1960 x 1897 pixels, FOV: 45 degrees.
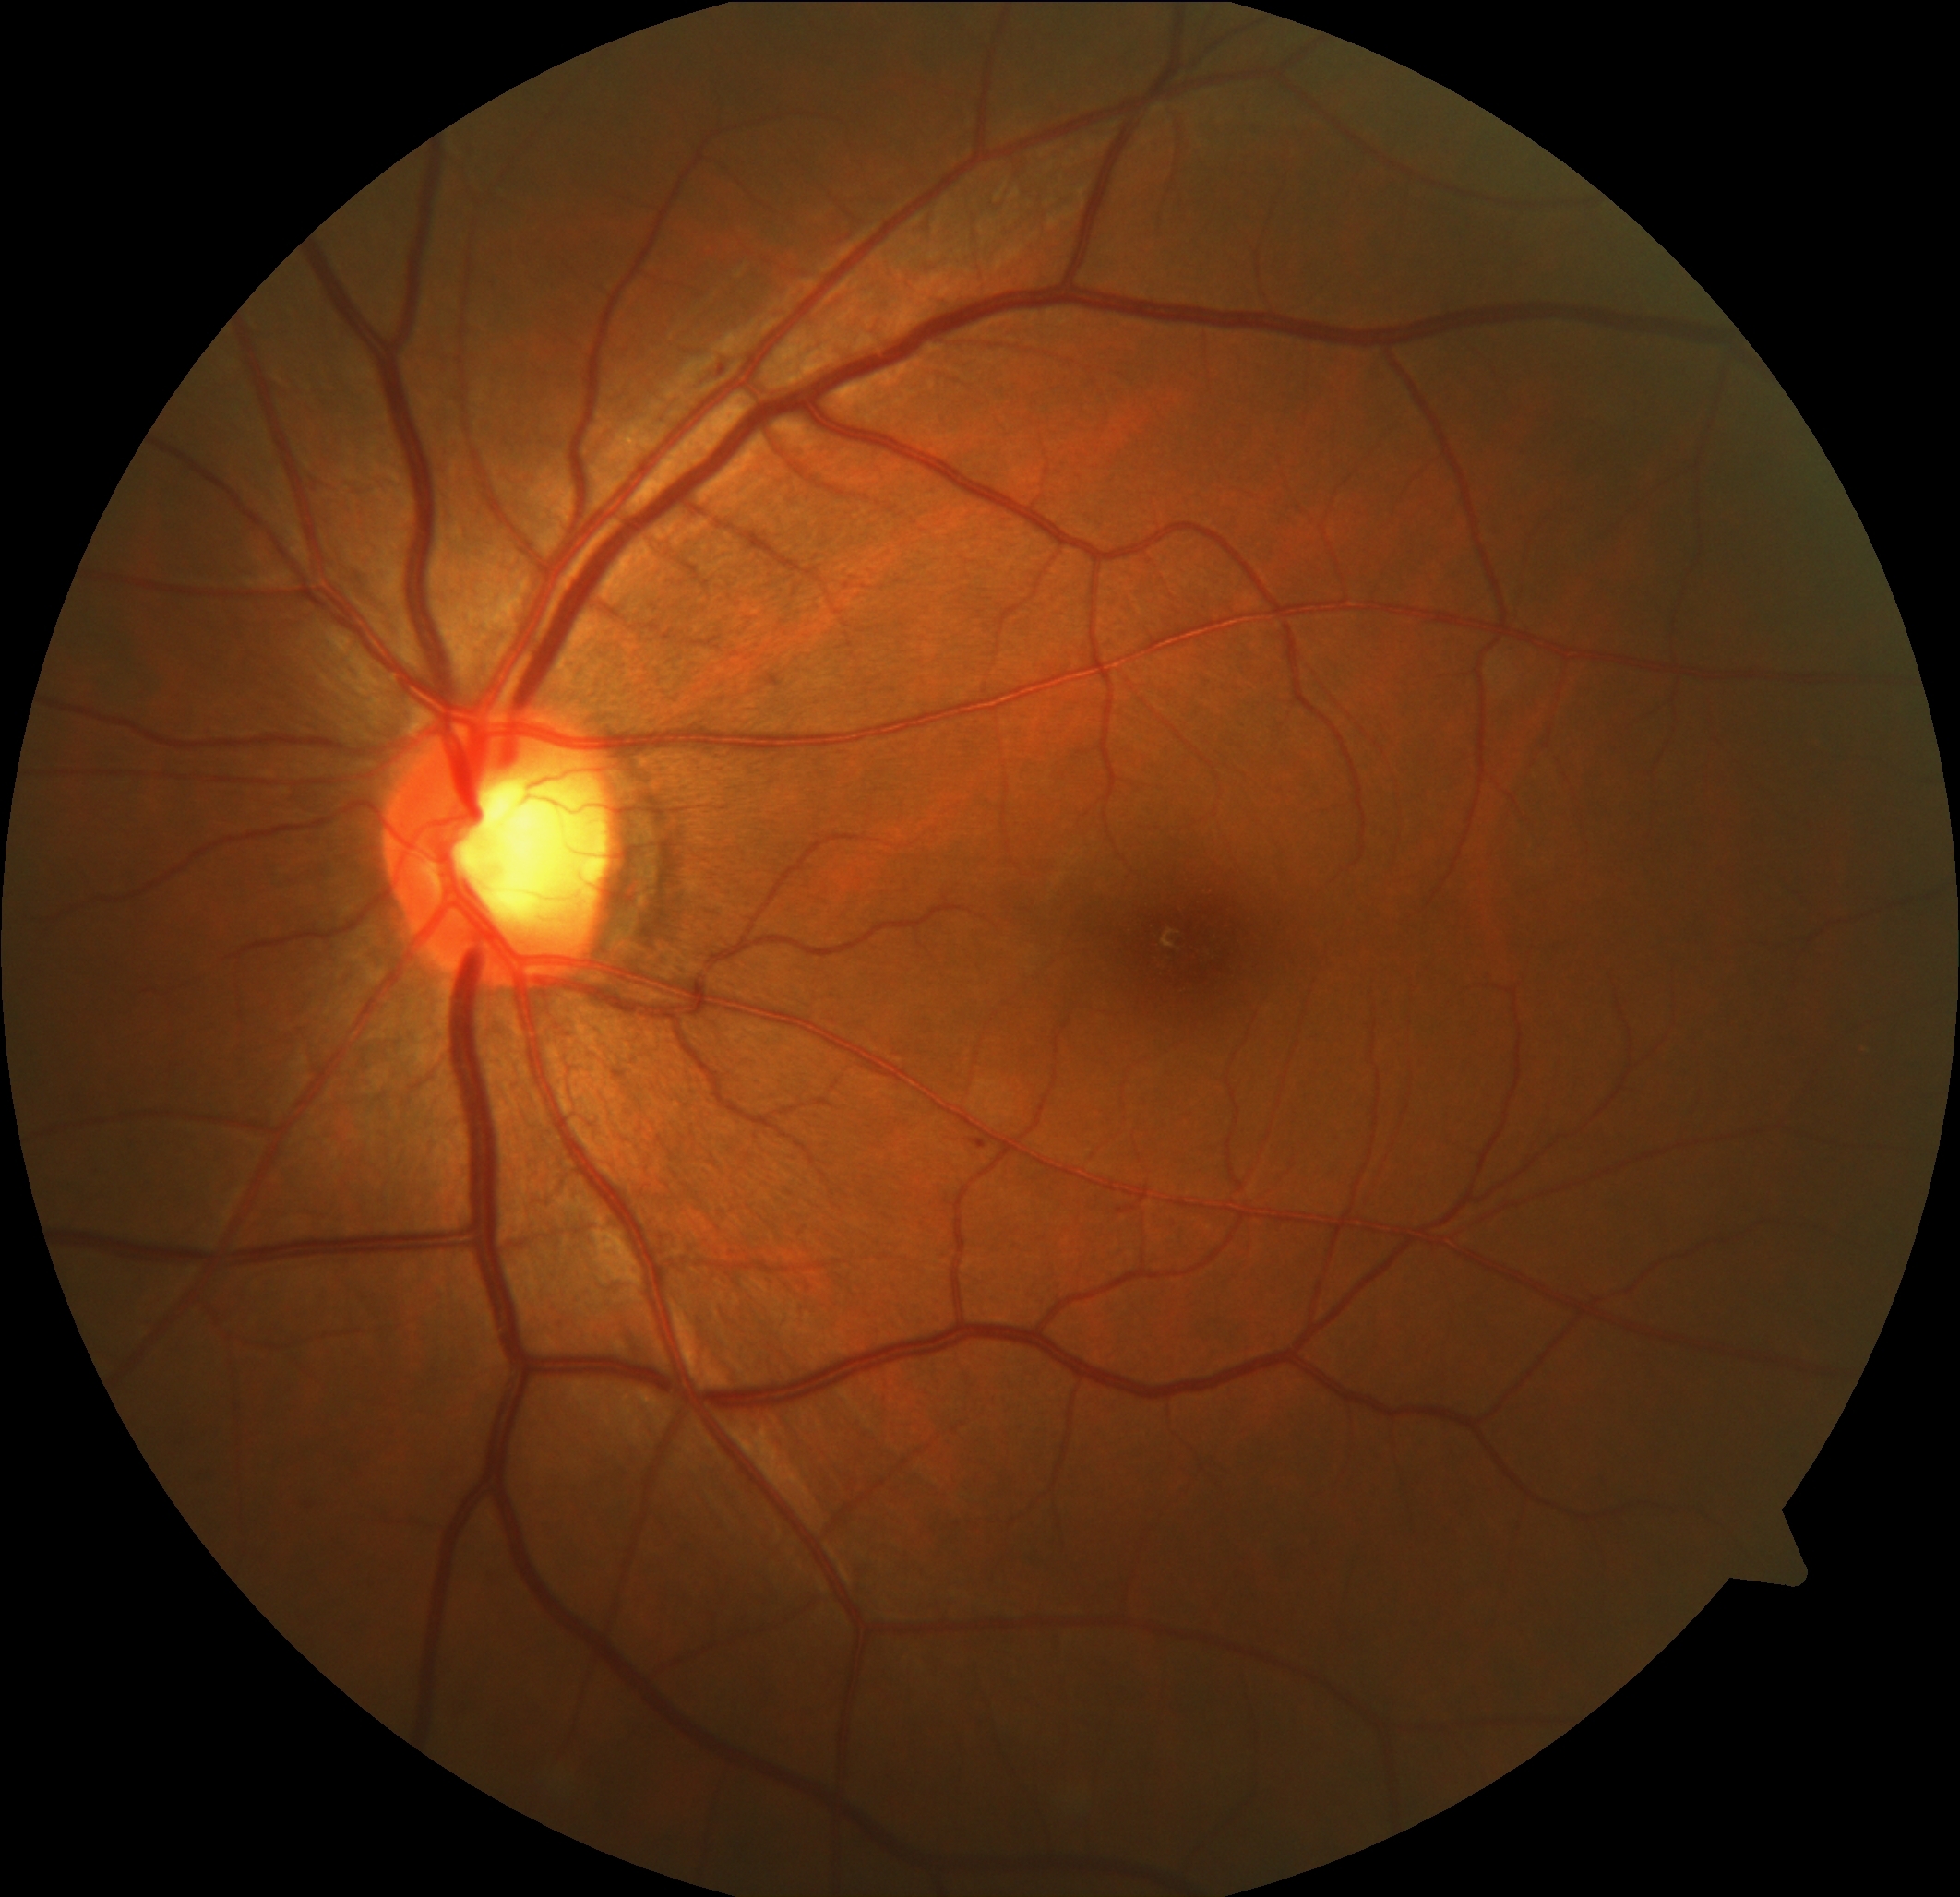 dr_grade: 1
lesions:
  ex: []
  he: []
  se: []
  ma:
    - {"left": 970, "top": 1139, "right": 989, "bottom": 1151}